Image size 848x848; color fundus photograph; NIDEK AFC-230 fundus camera:
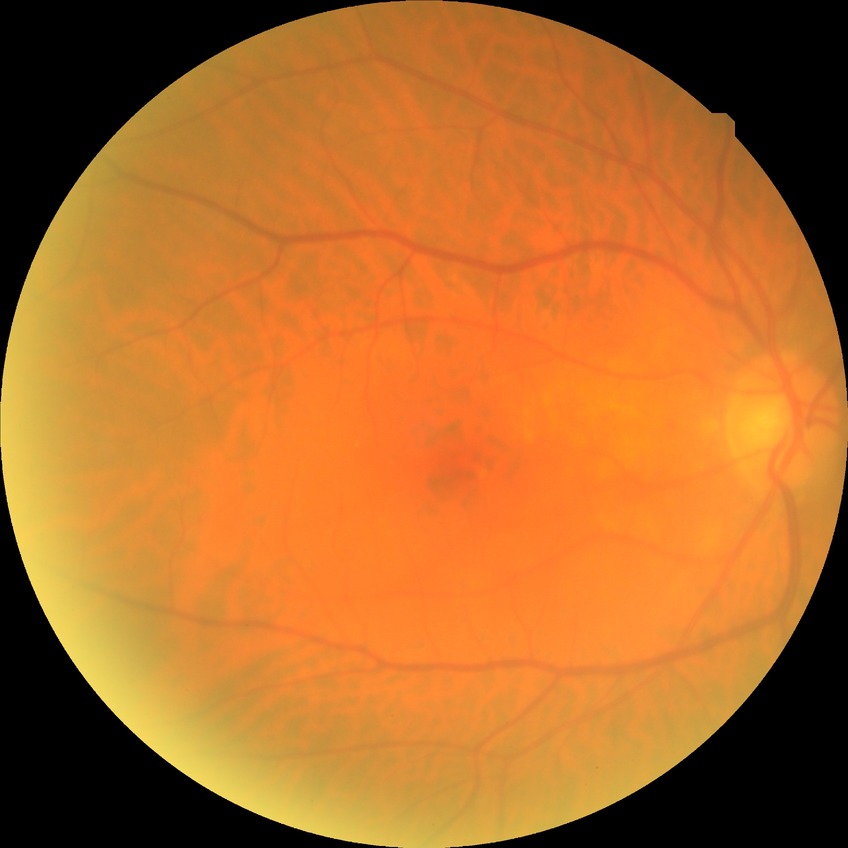
diabetic retinopathy (DR) = no diabetic retinopathy (NDR)